Color fundus image:
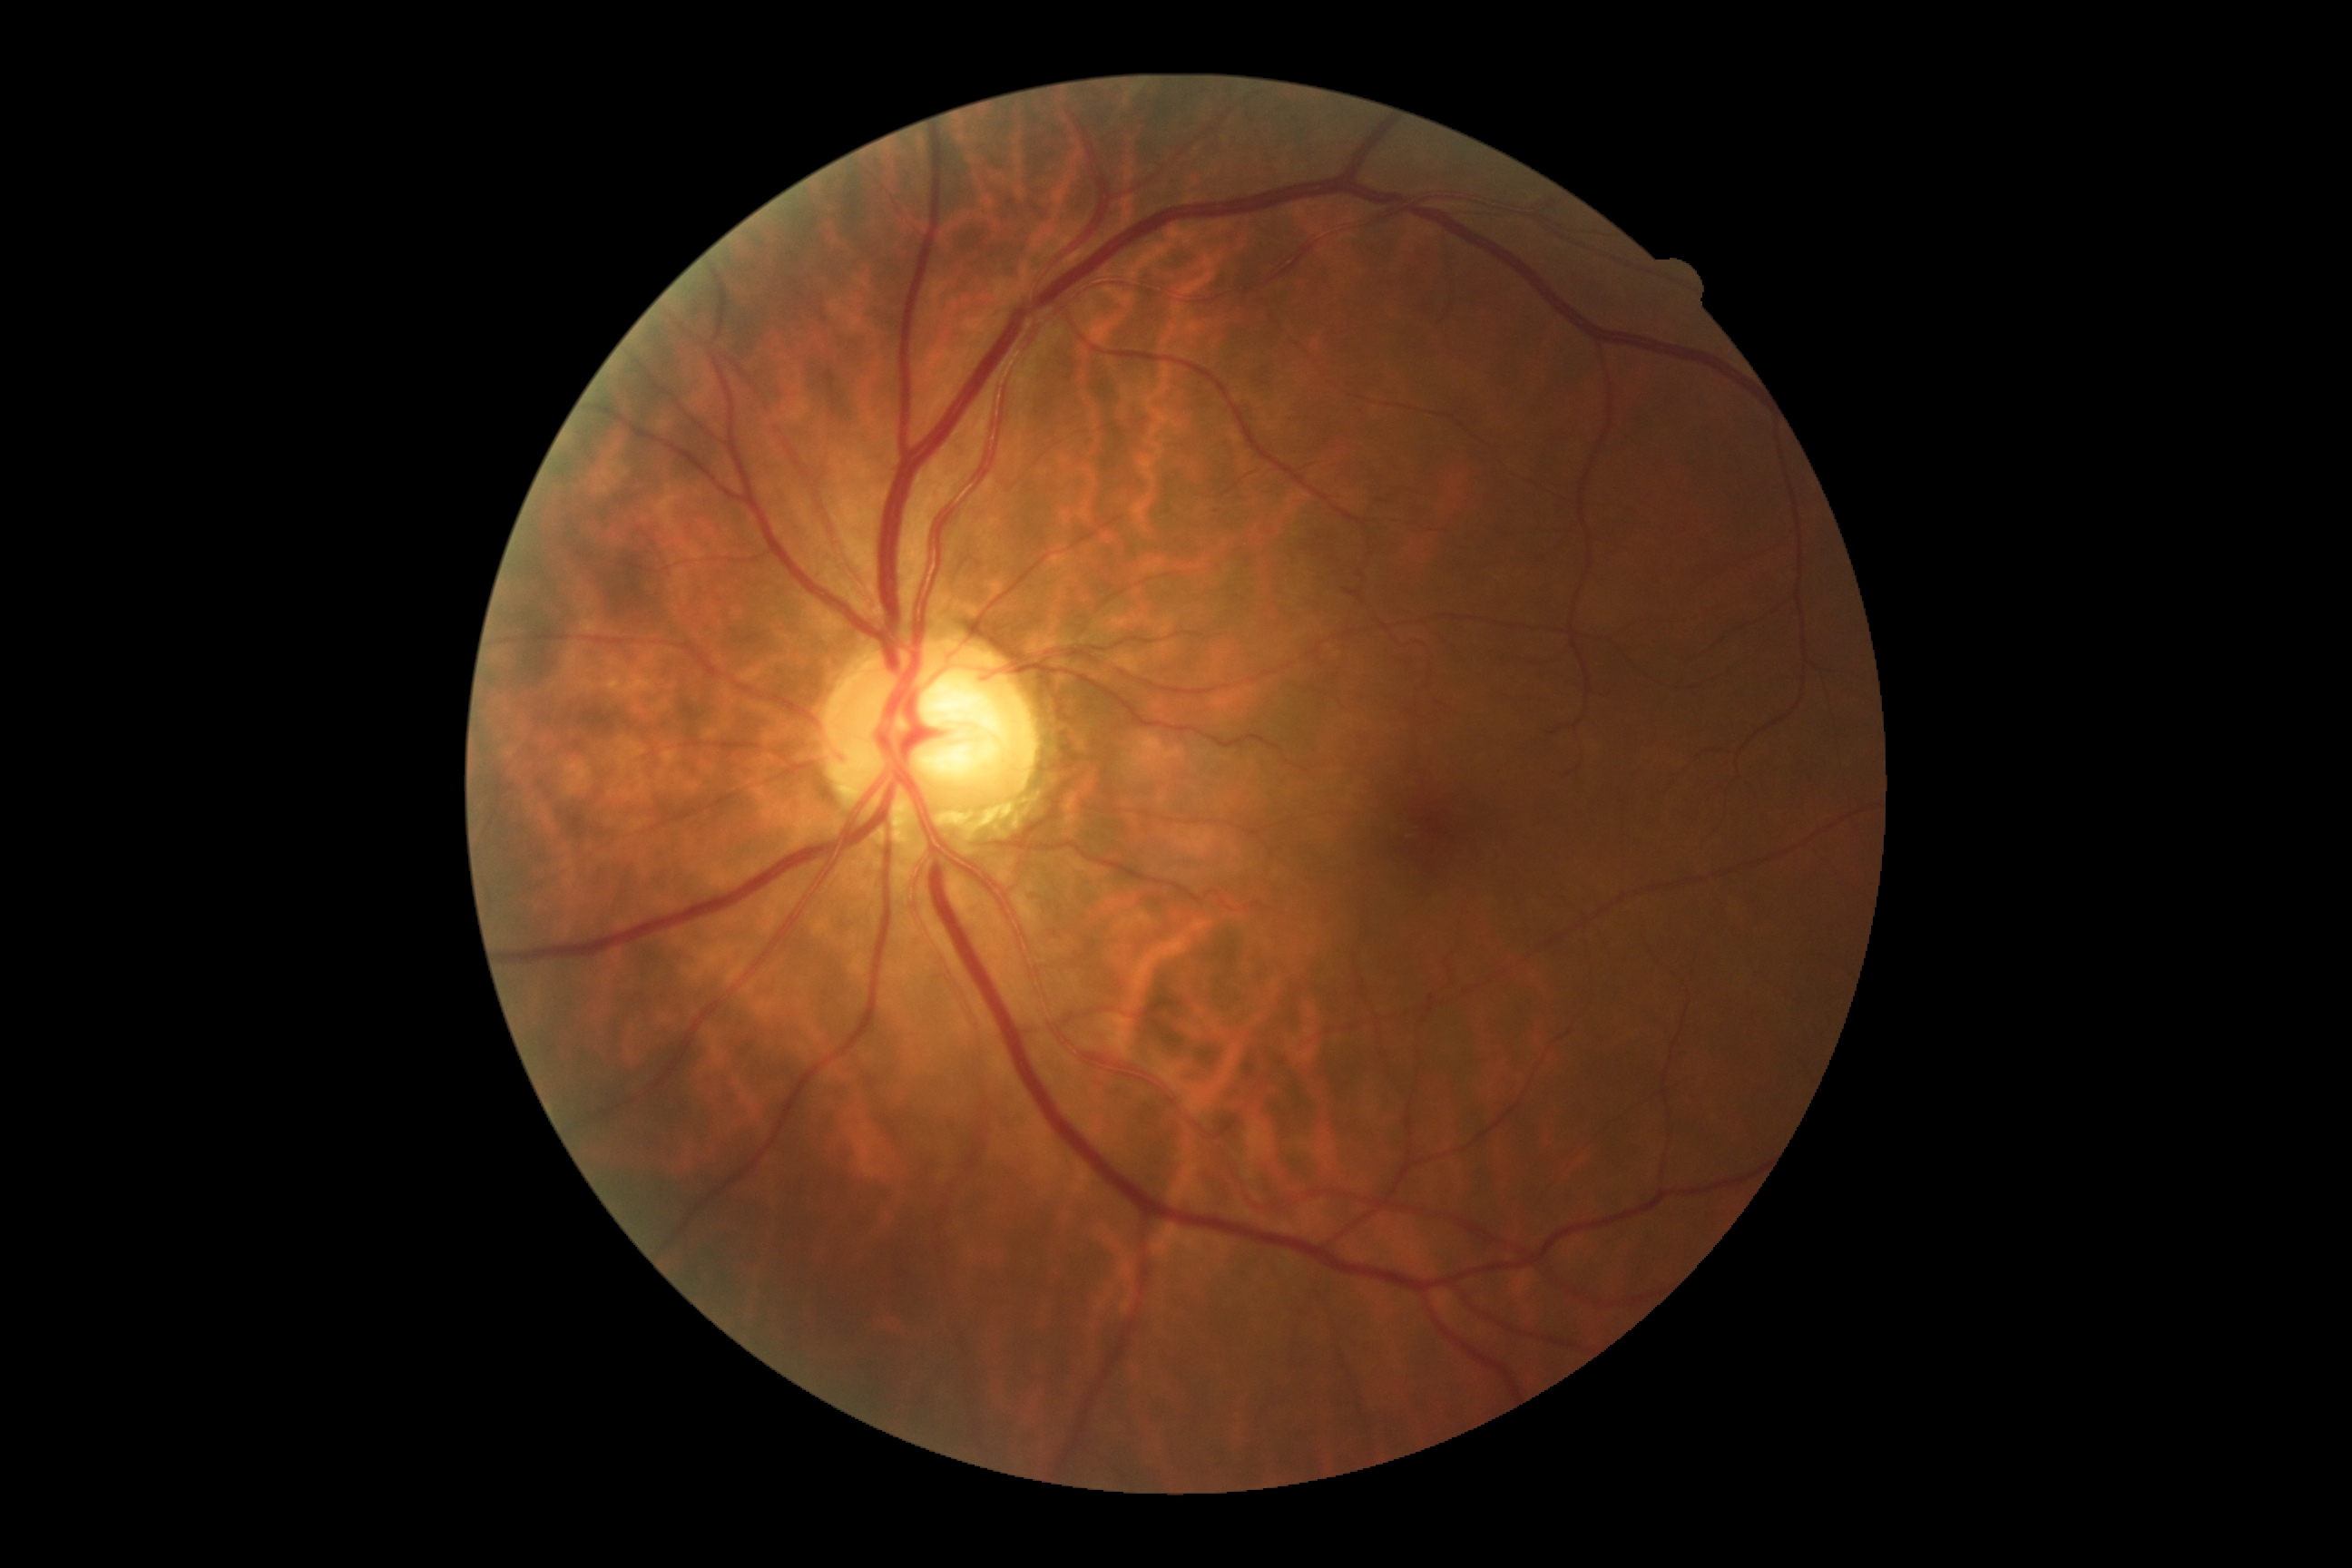
DR severity is 0/4.